848 x 848 pixels; 45° FOV; NIDEK AFC-230 — 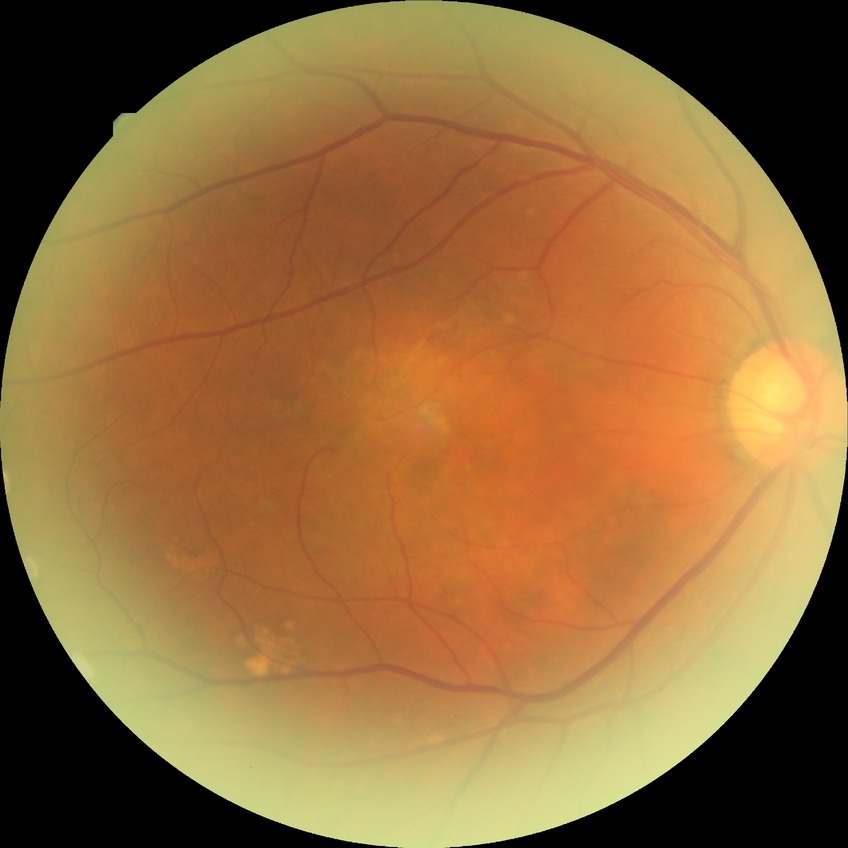
Diabetic retinopathy severity: no diabetic retinopathy.